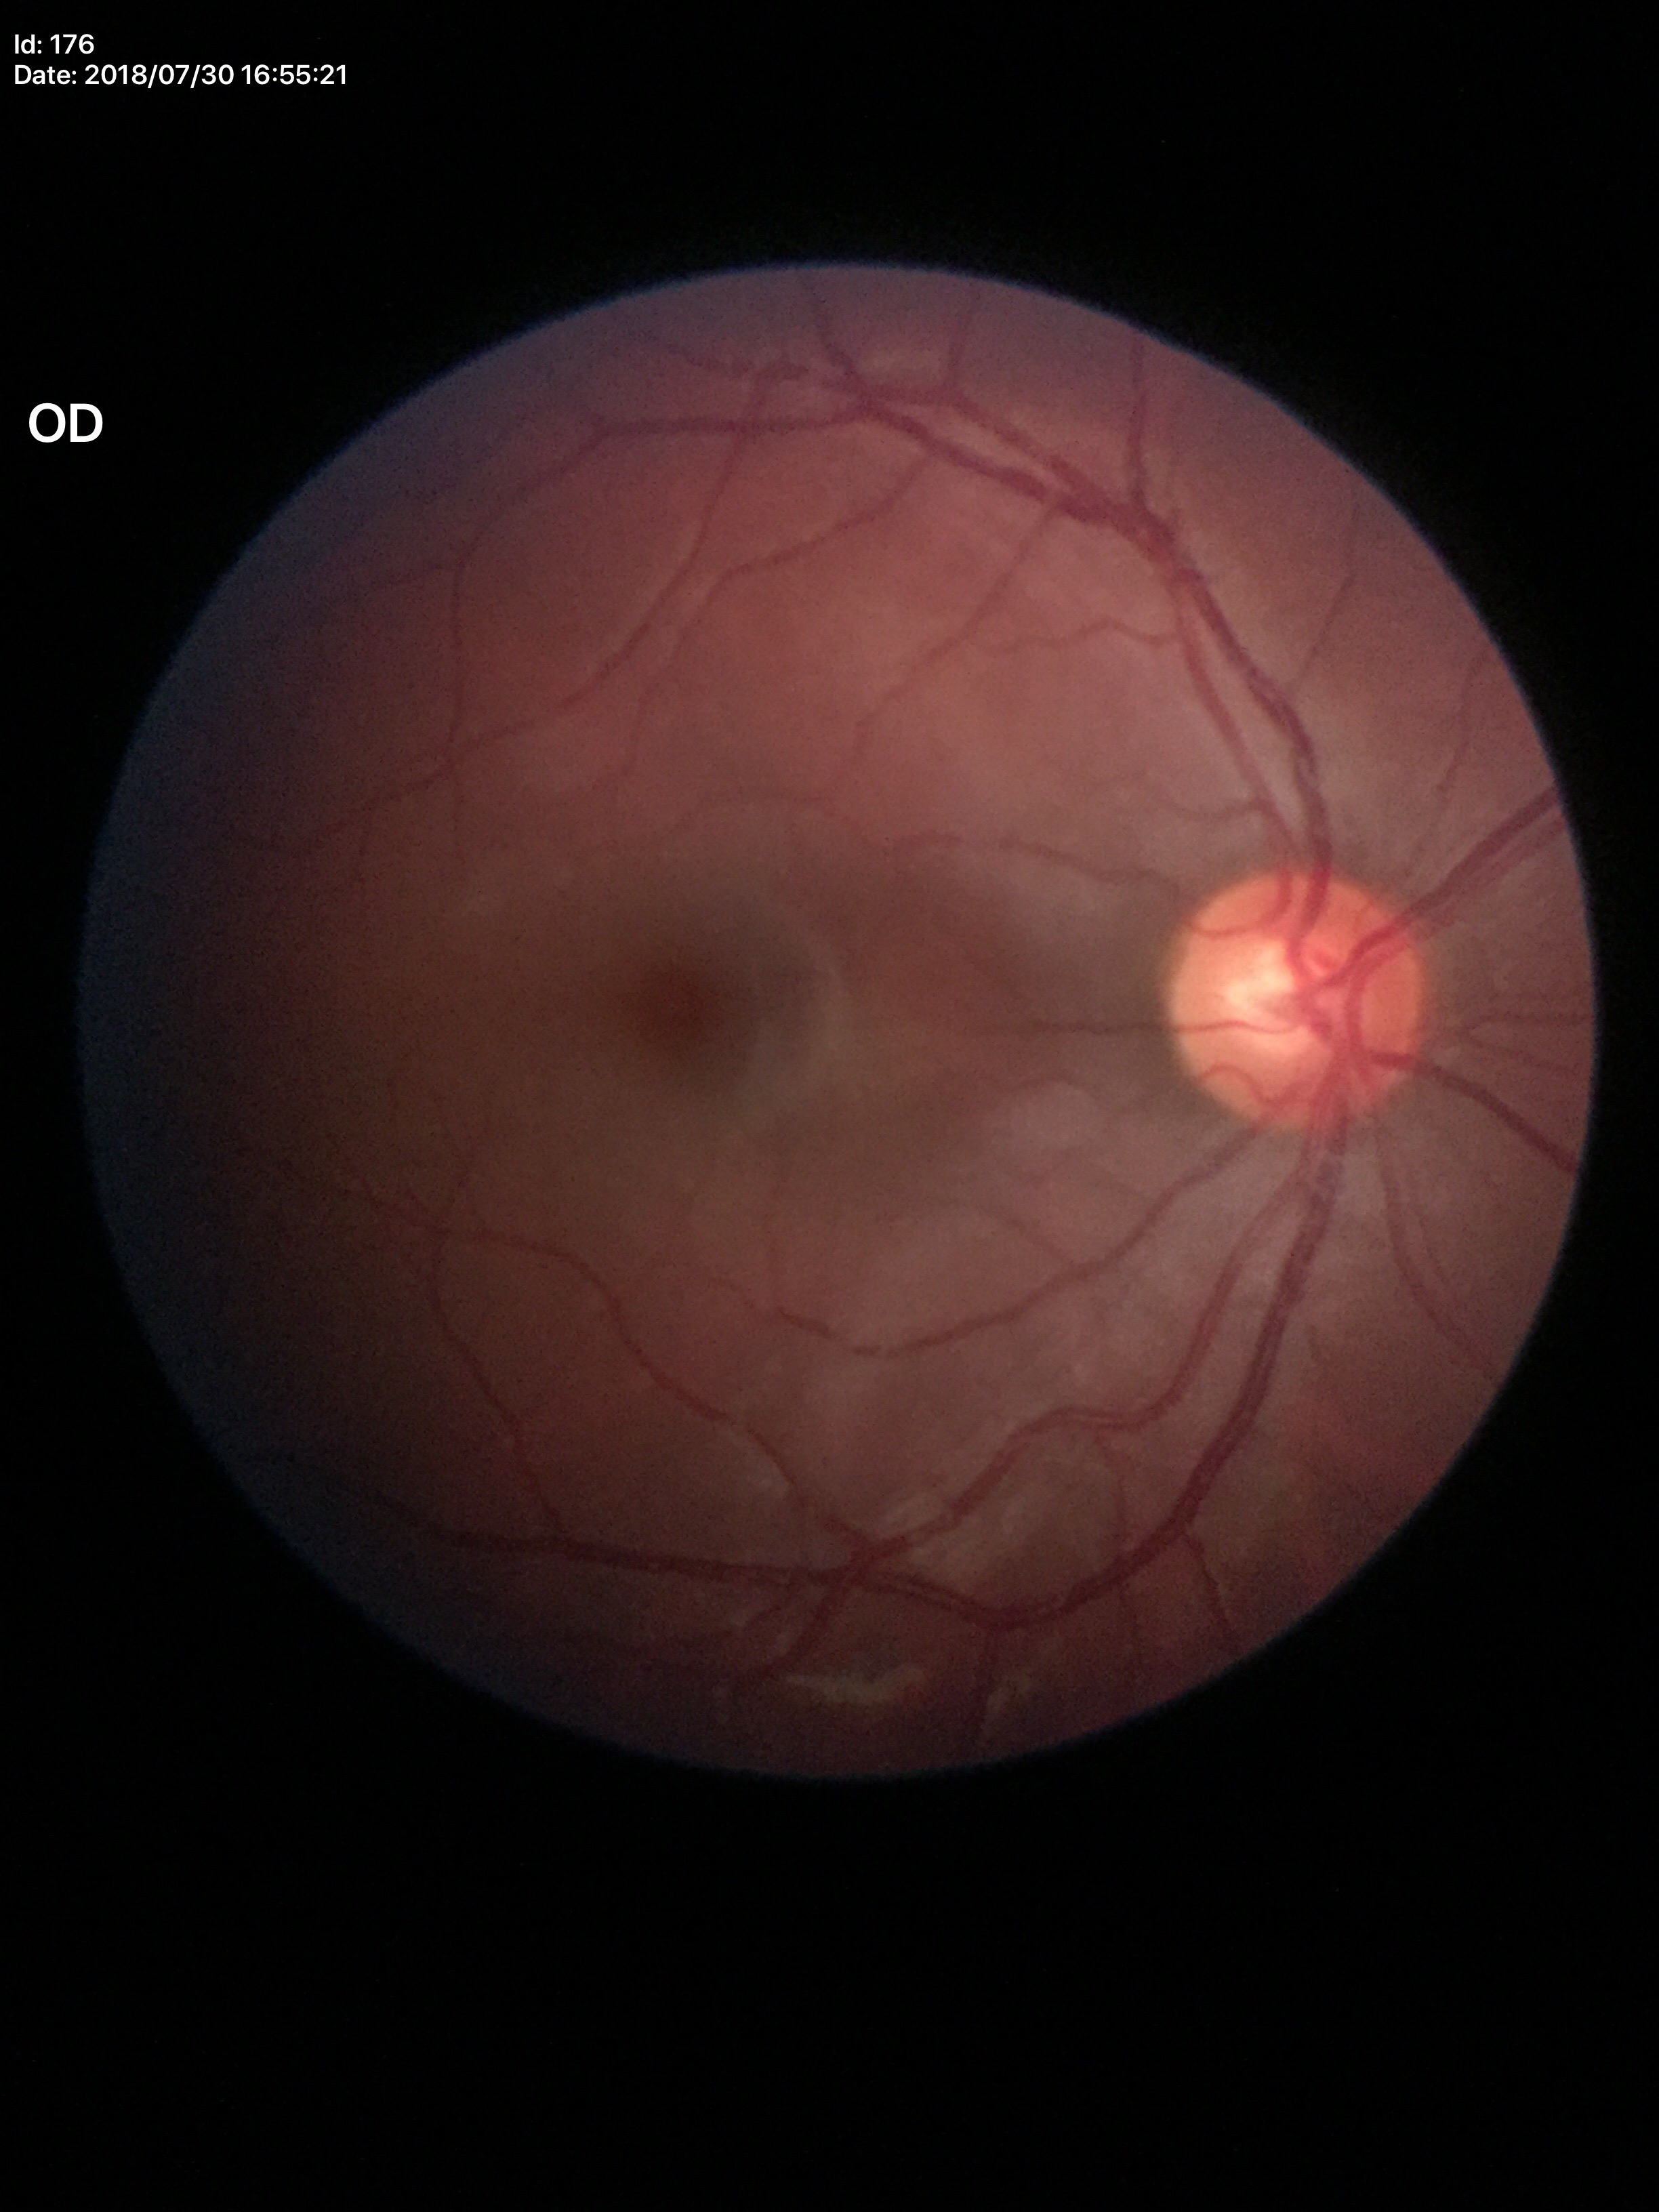
Glaucoma impression: not suspect | VCDR: 0.59.